FOV: 45 degrees
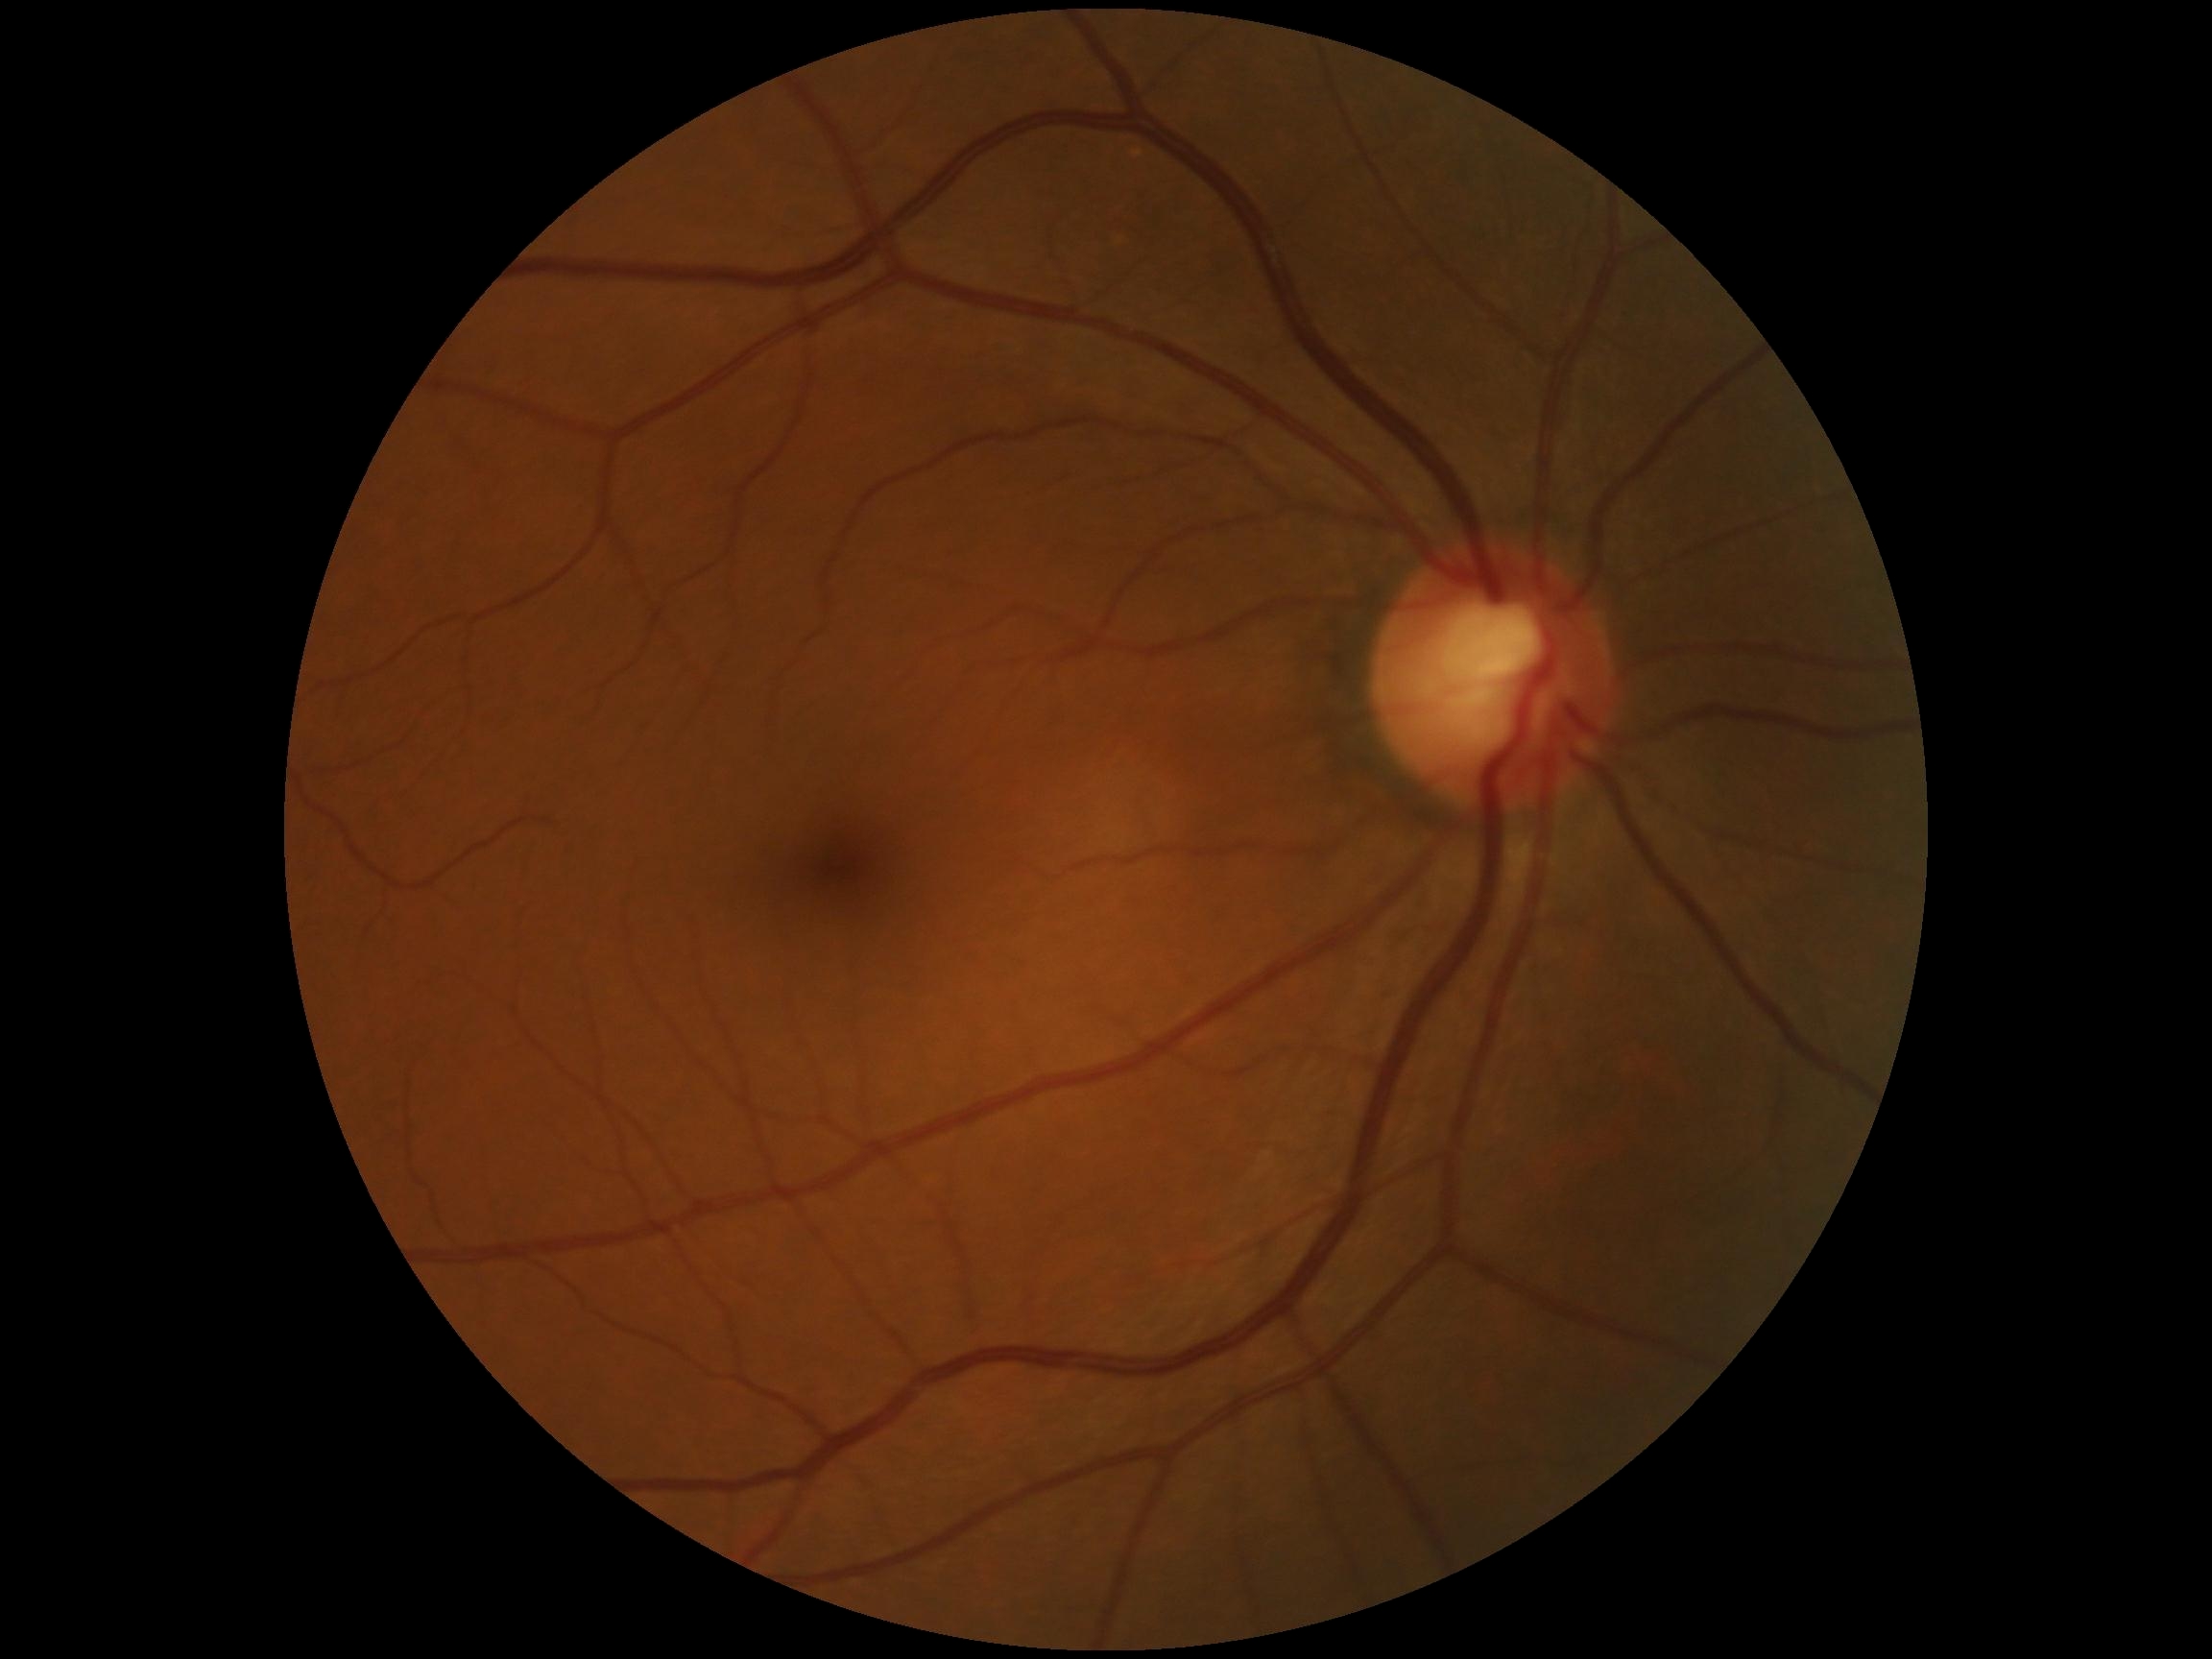
Diabetic retinopathy grade: 0 (no apparent retinopathy).
No DR findings.